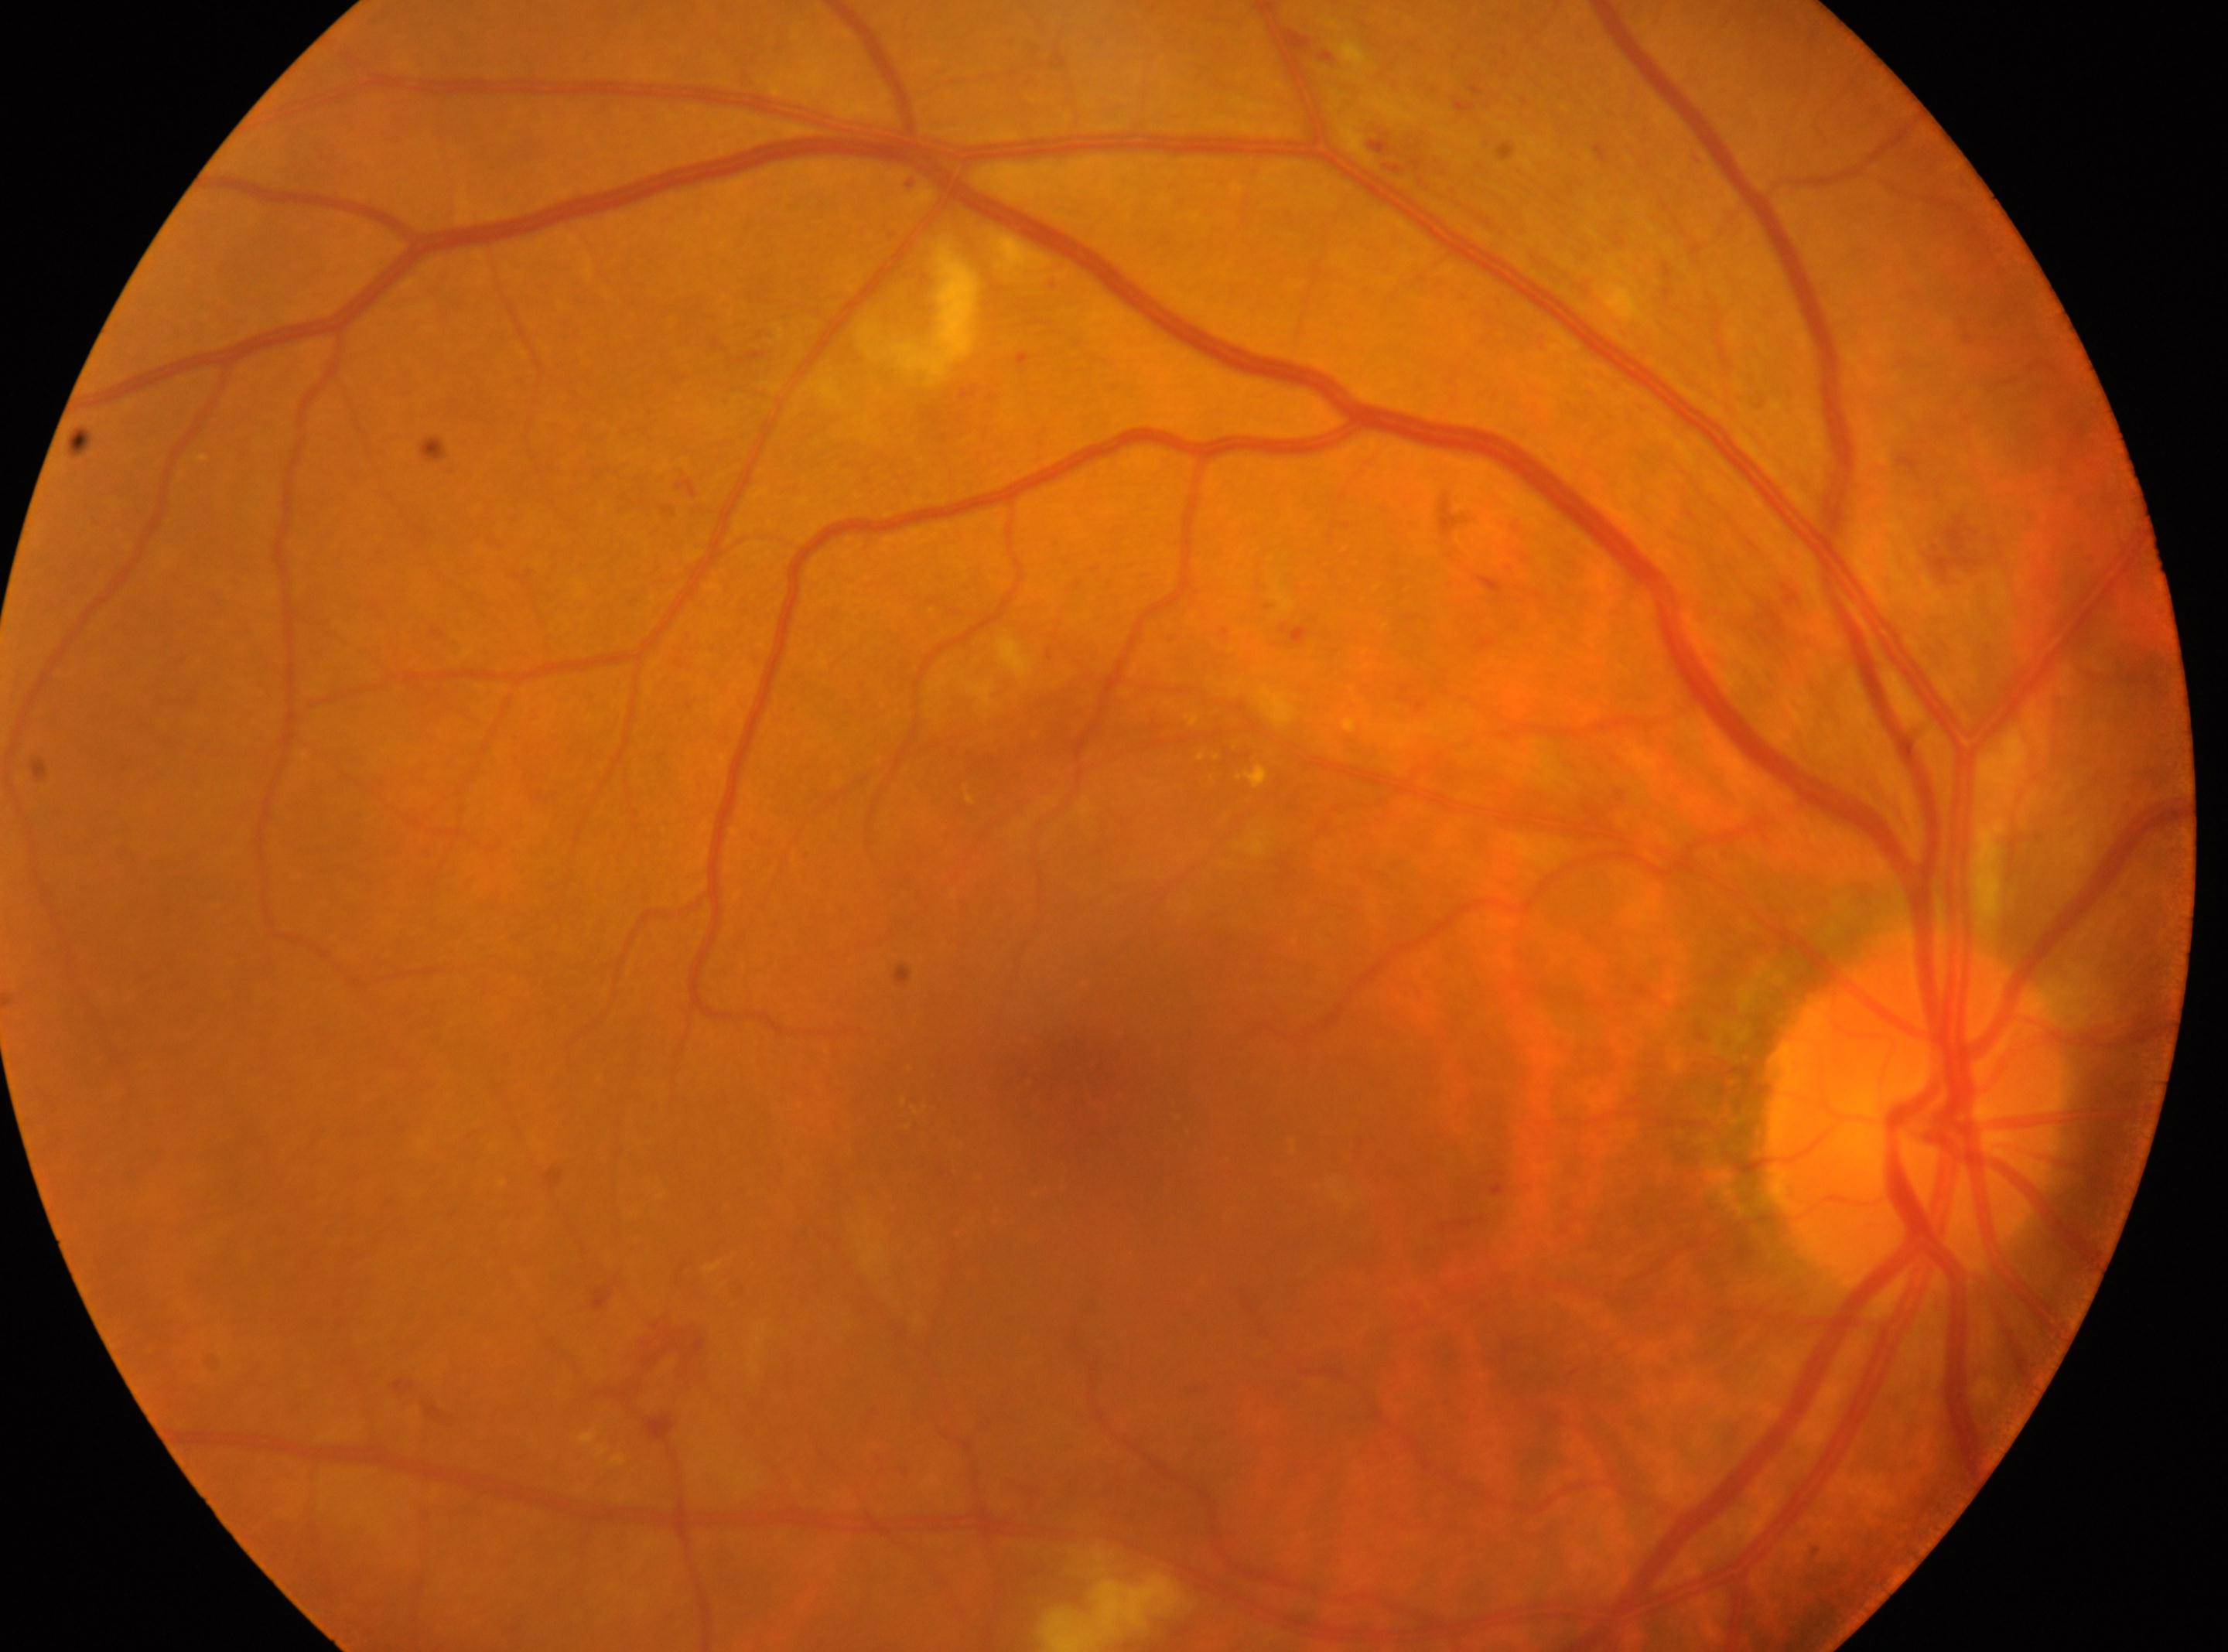
DR grade: 2.
Fovea centralis: 1072, 1060.
The optic nerve head is at 1912, 1117.
Imaged eye: right.